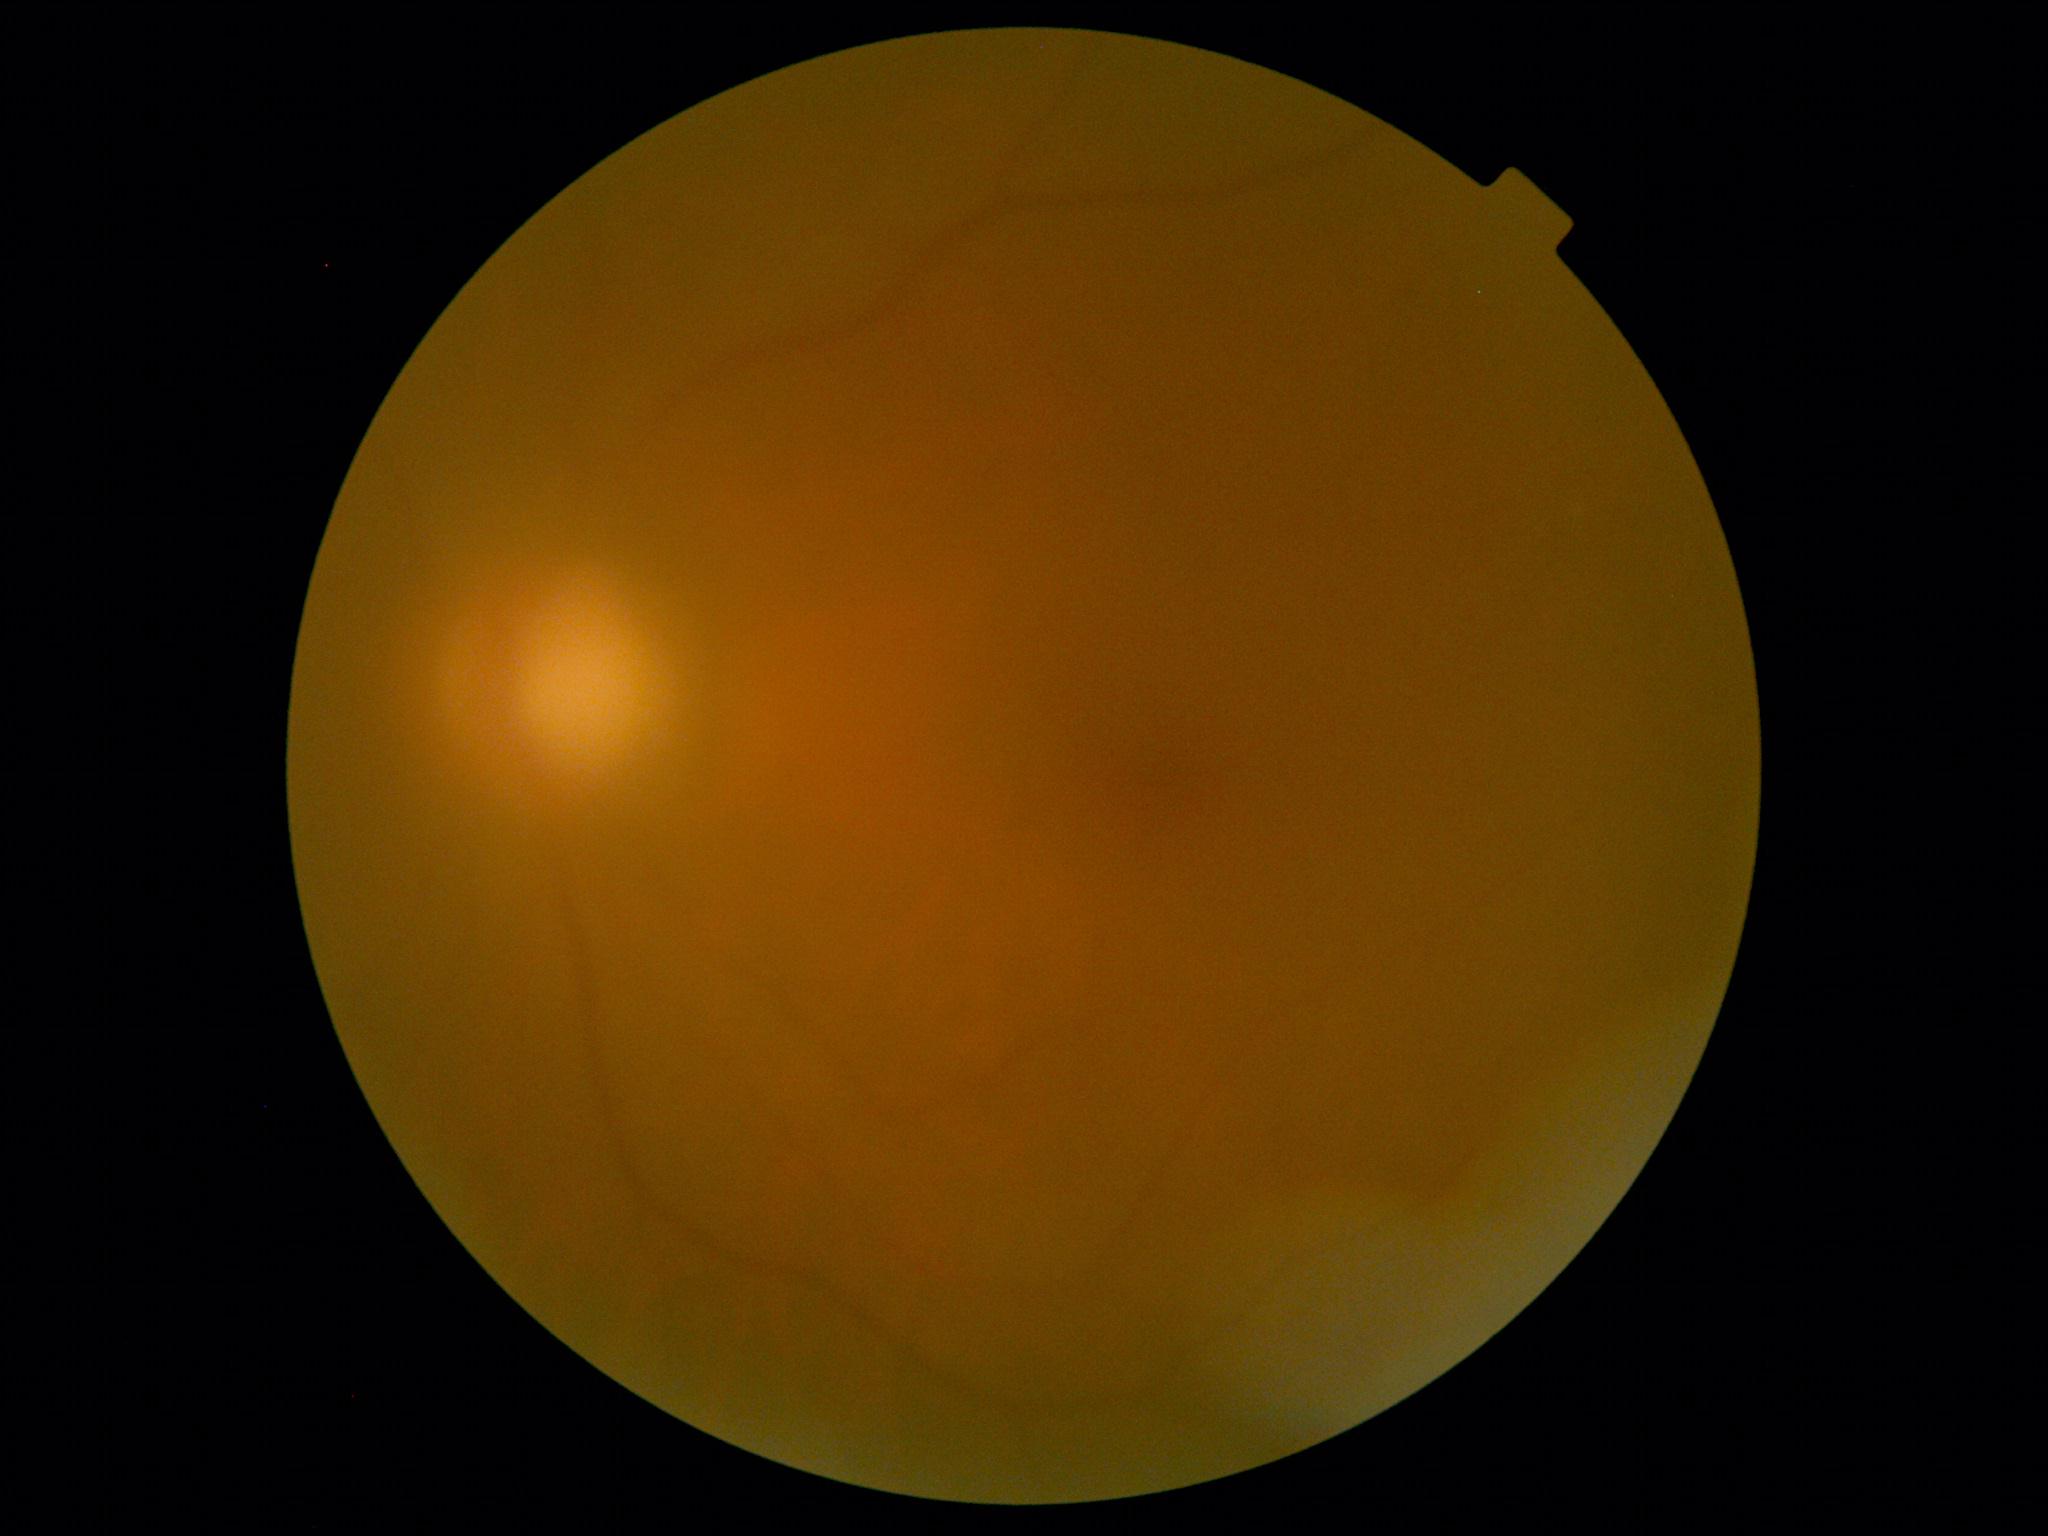

retinopathy grade = ungradable due to poor image quality